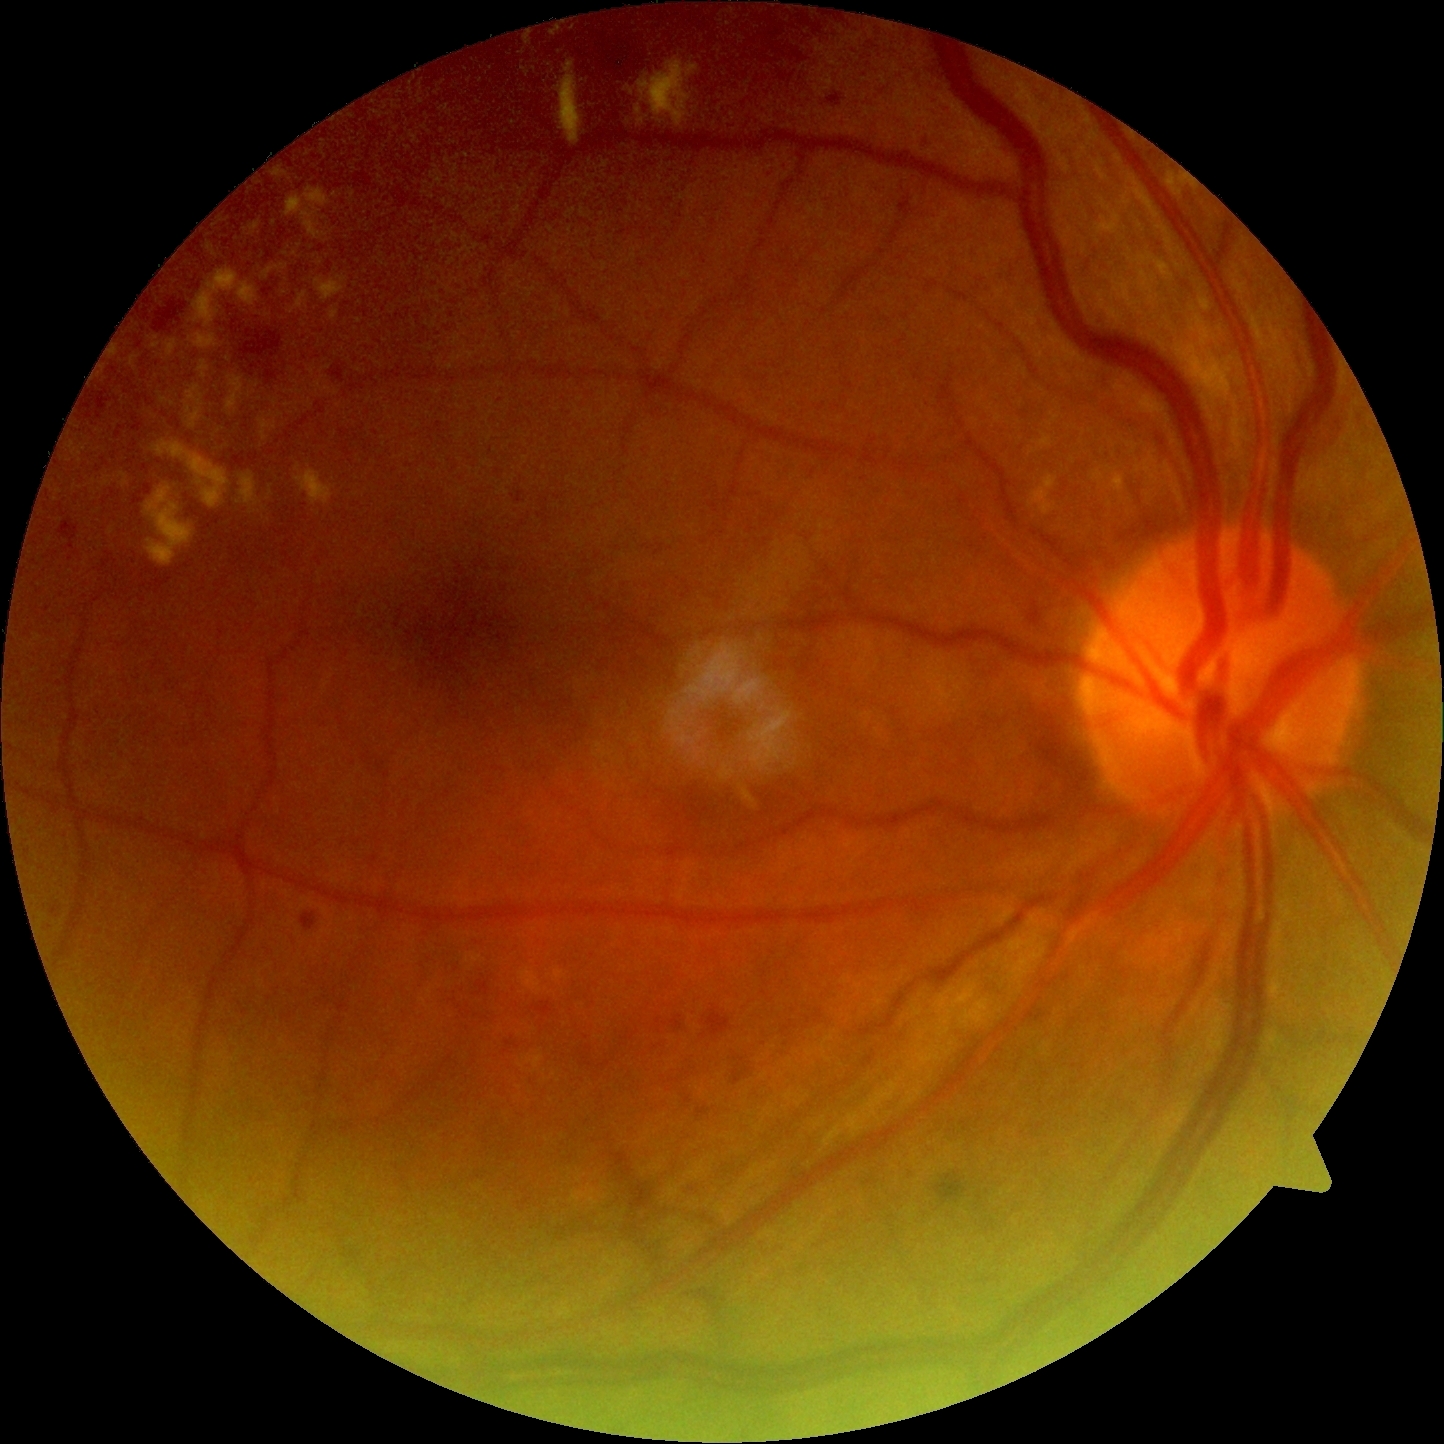
DR grade = 2 (moderate NPDR).